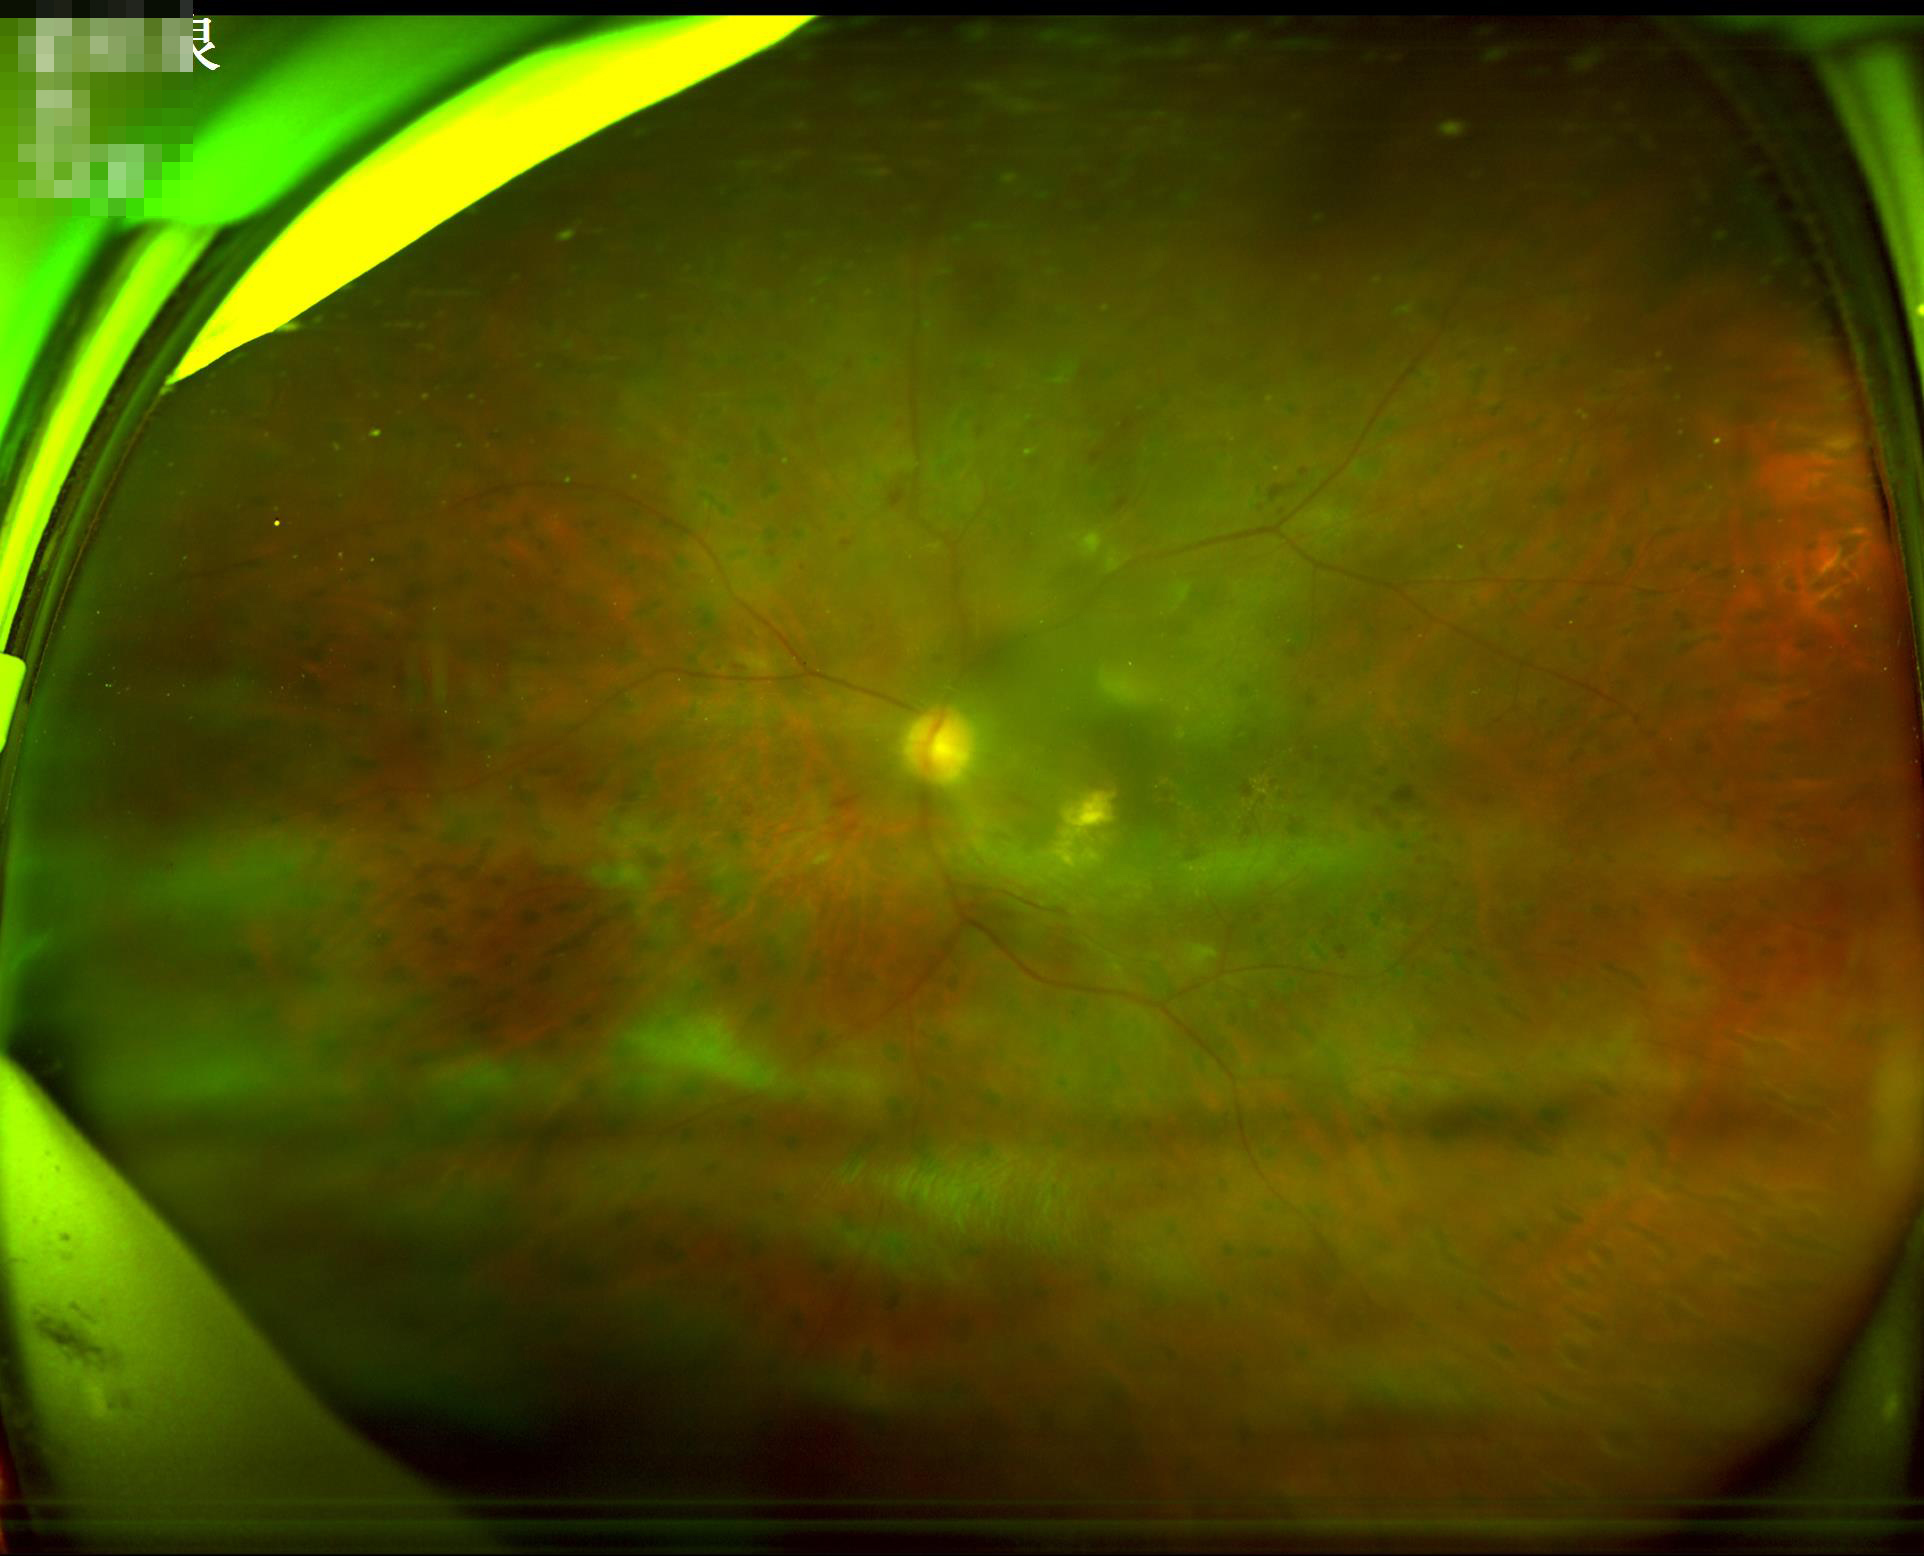

Contrast = wide intensity range, structures distinguishable | Overall = poor and difficult to use diagnostically | Illumination/color = even and well-balanced | Sharpness = reduced sharpness with visible blur.